Nonmydriatic fundus photograph; NIDEK AFC-230: 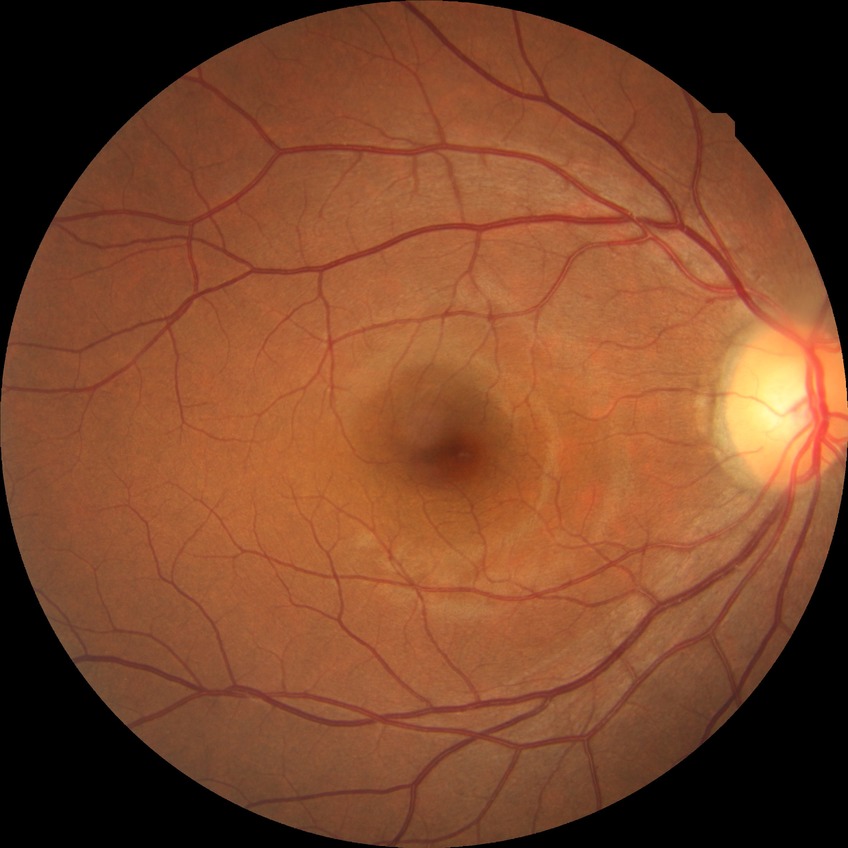

diabetic retinopathy (DR) = no diabetic retinopathy (NDR).